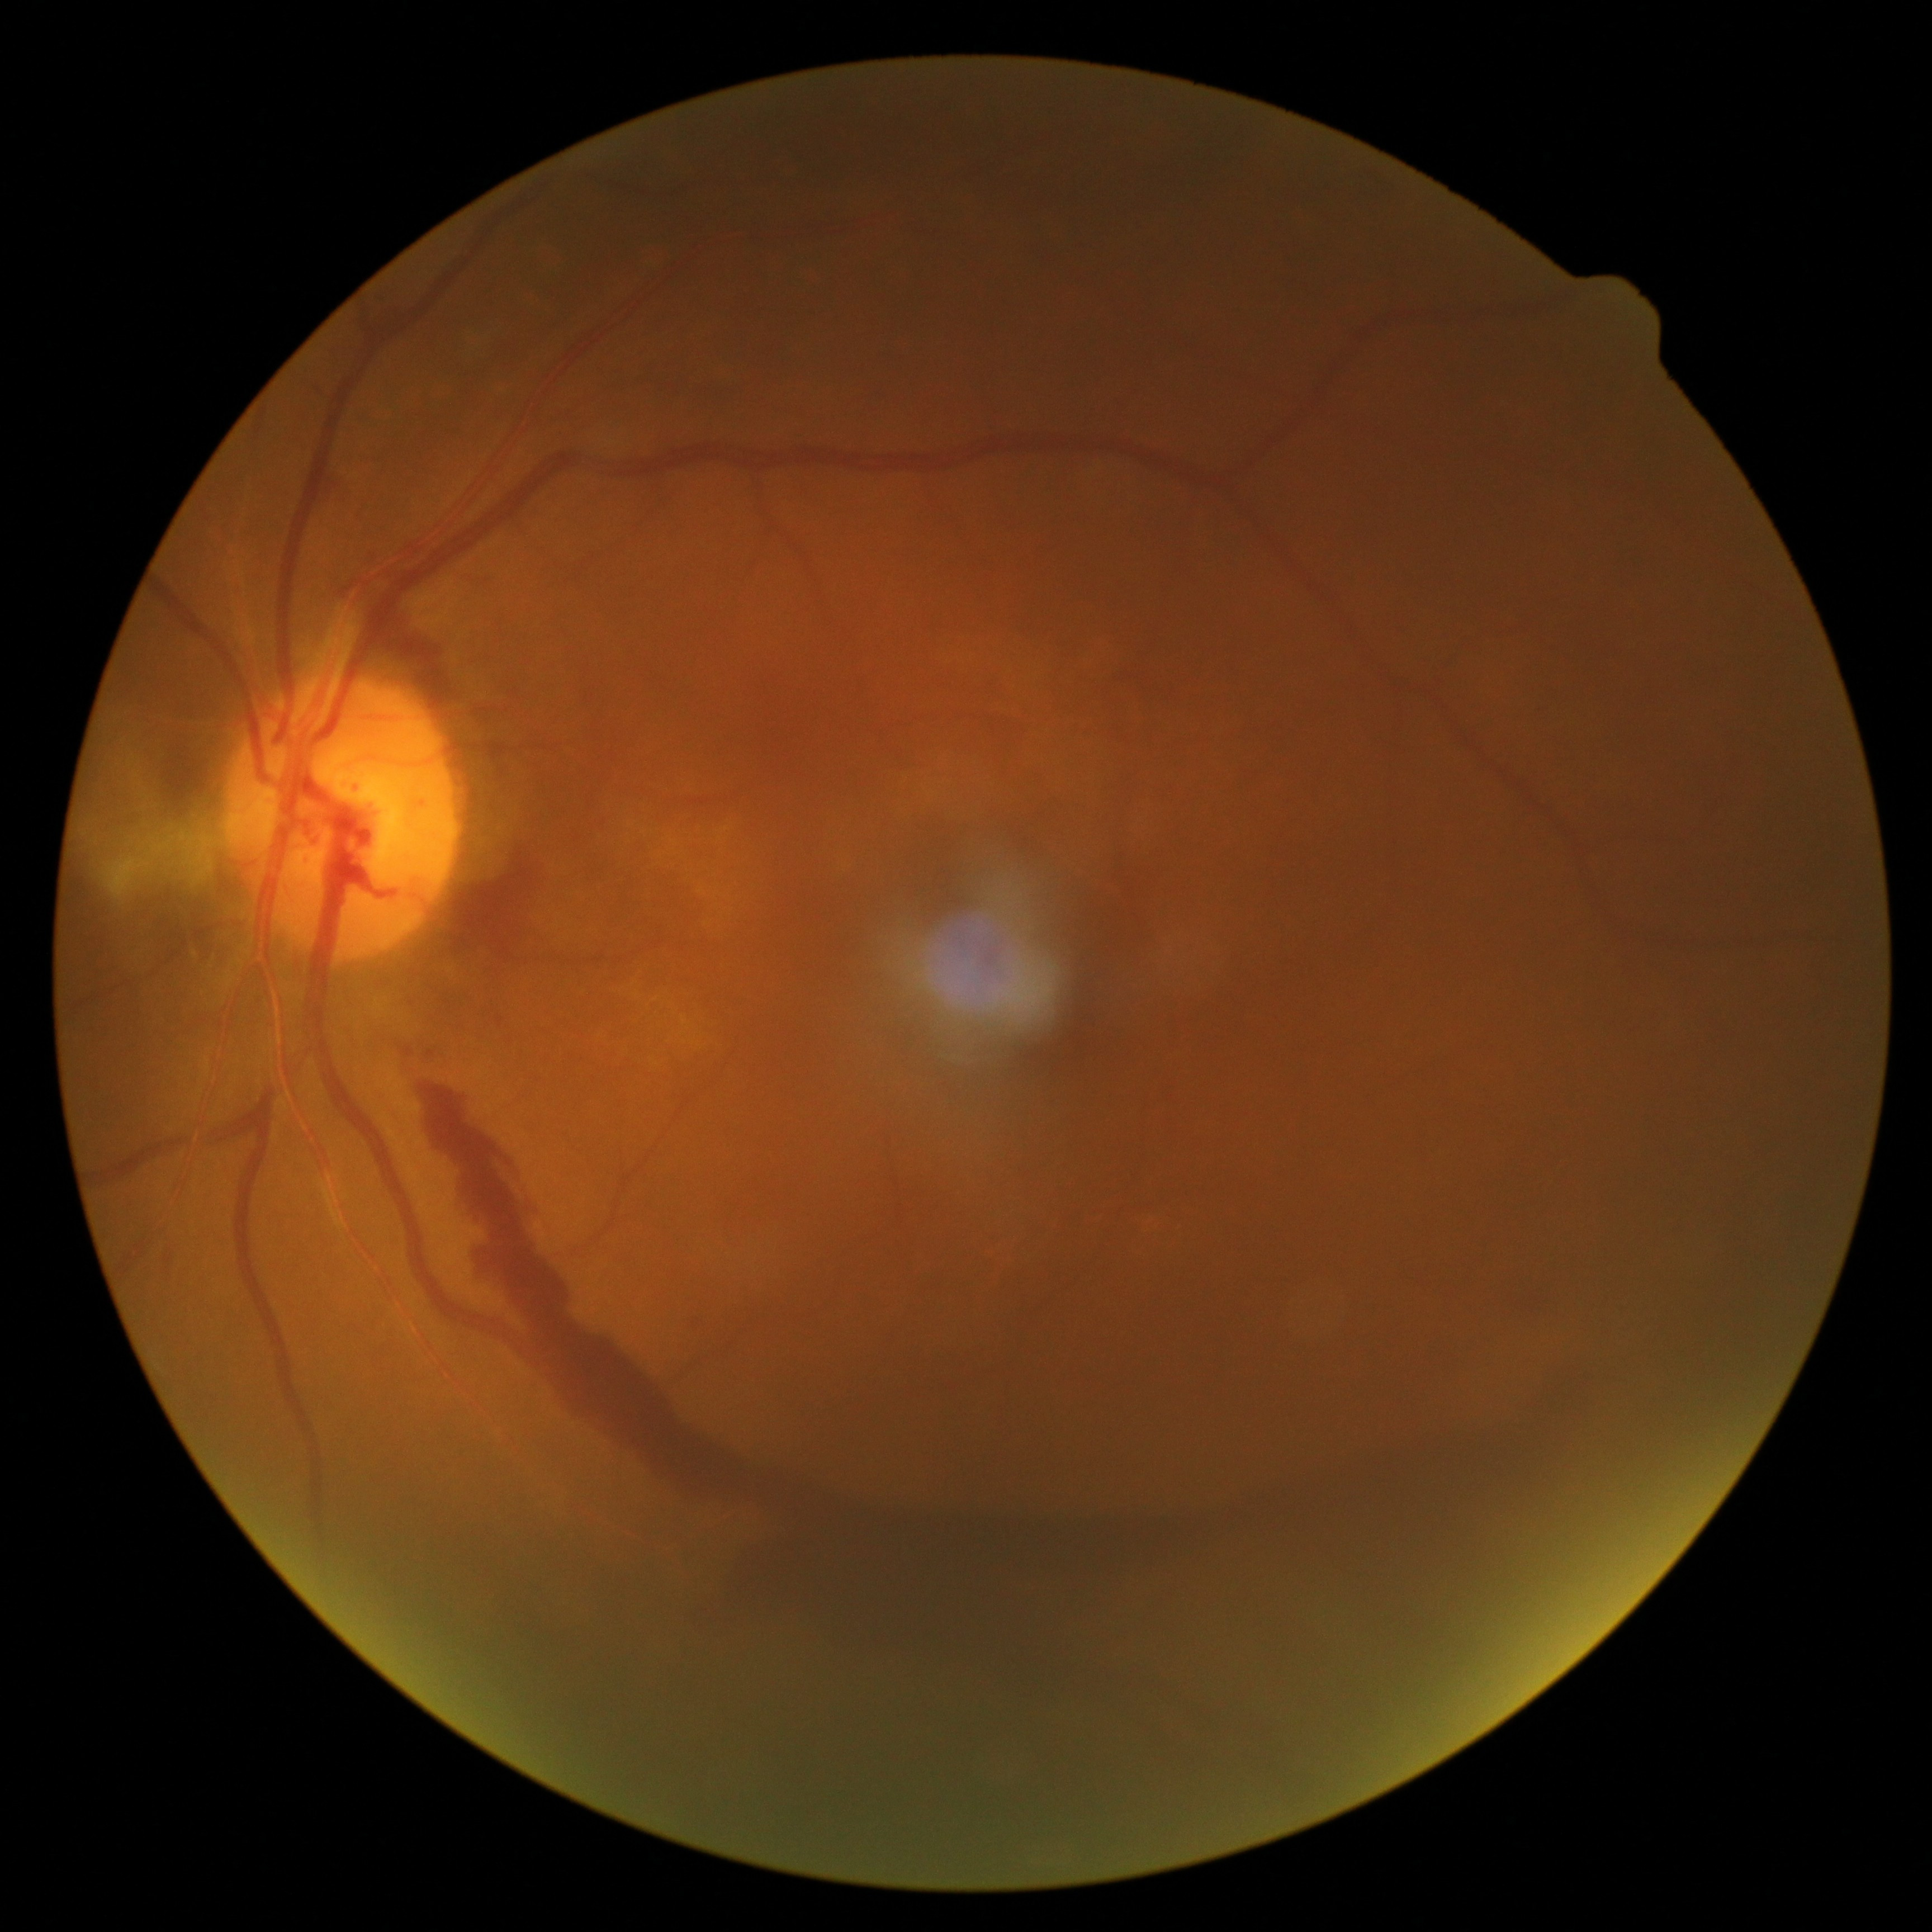 Diabetic retinopathy (DR): 4/4.